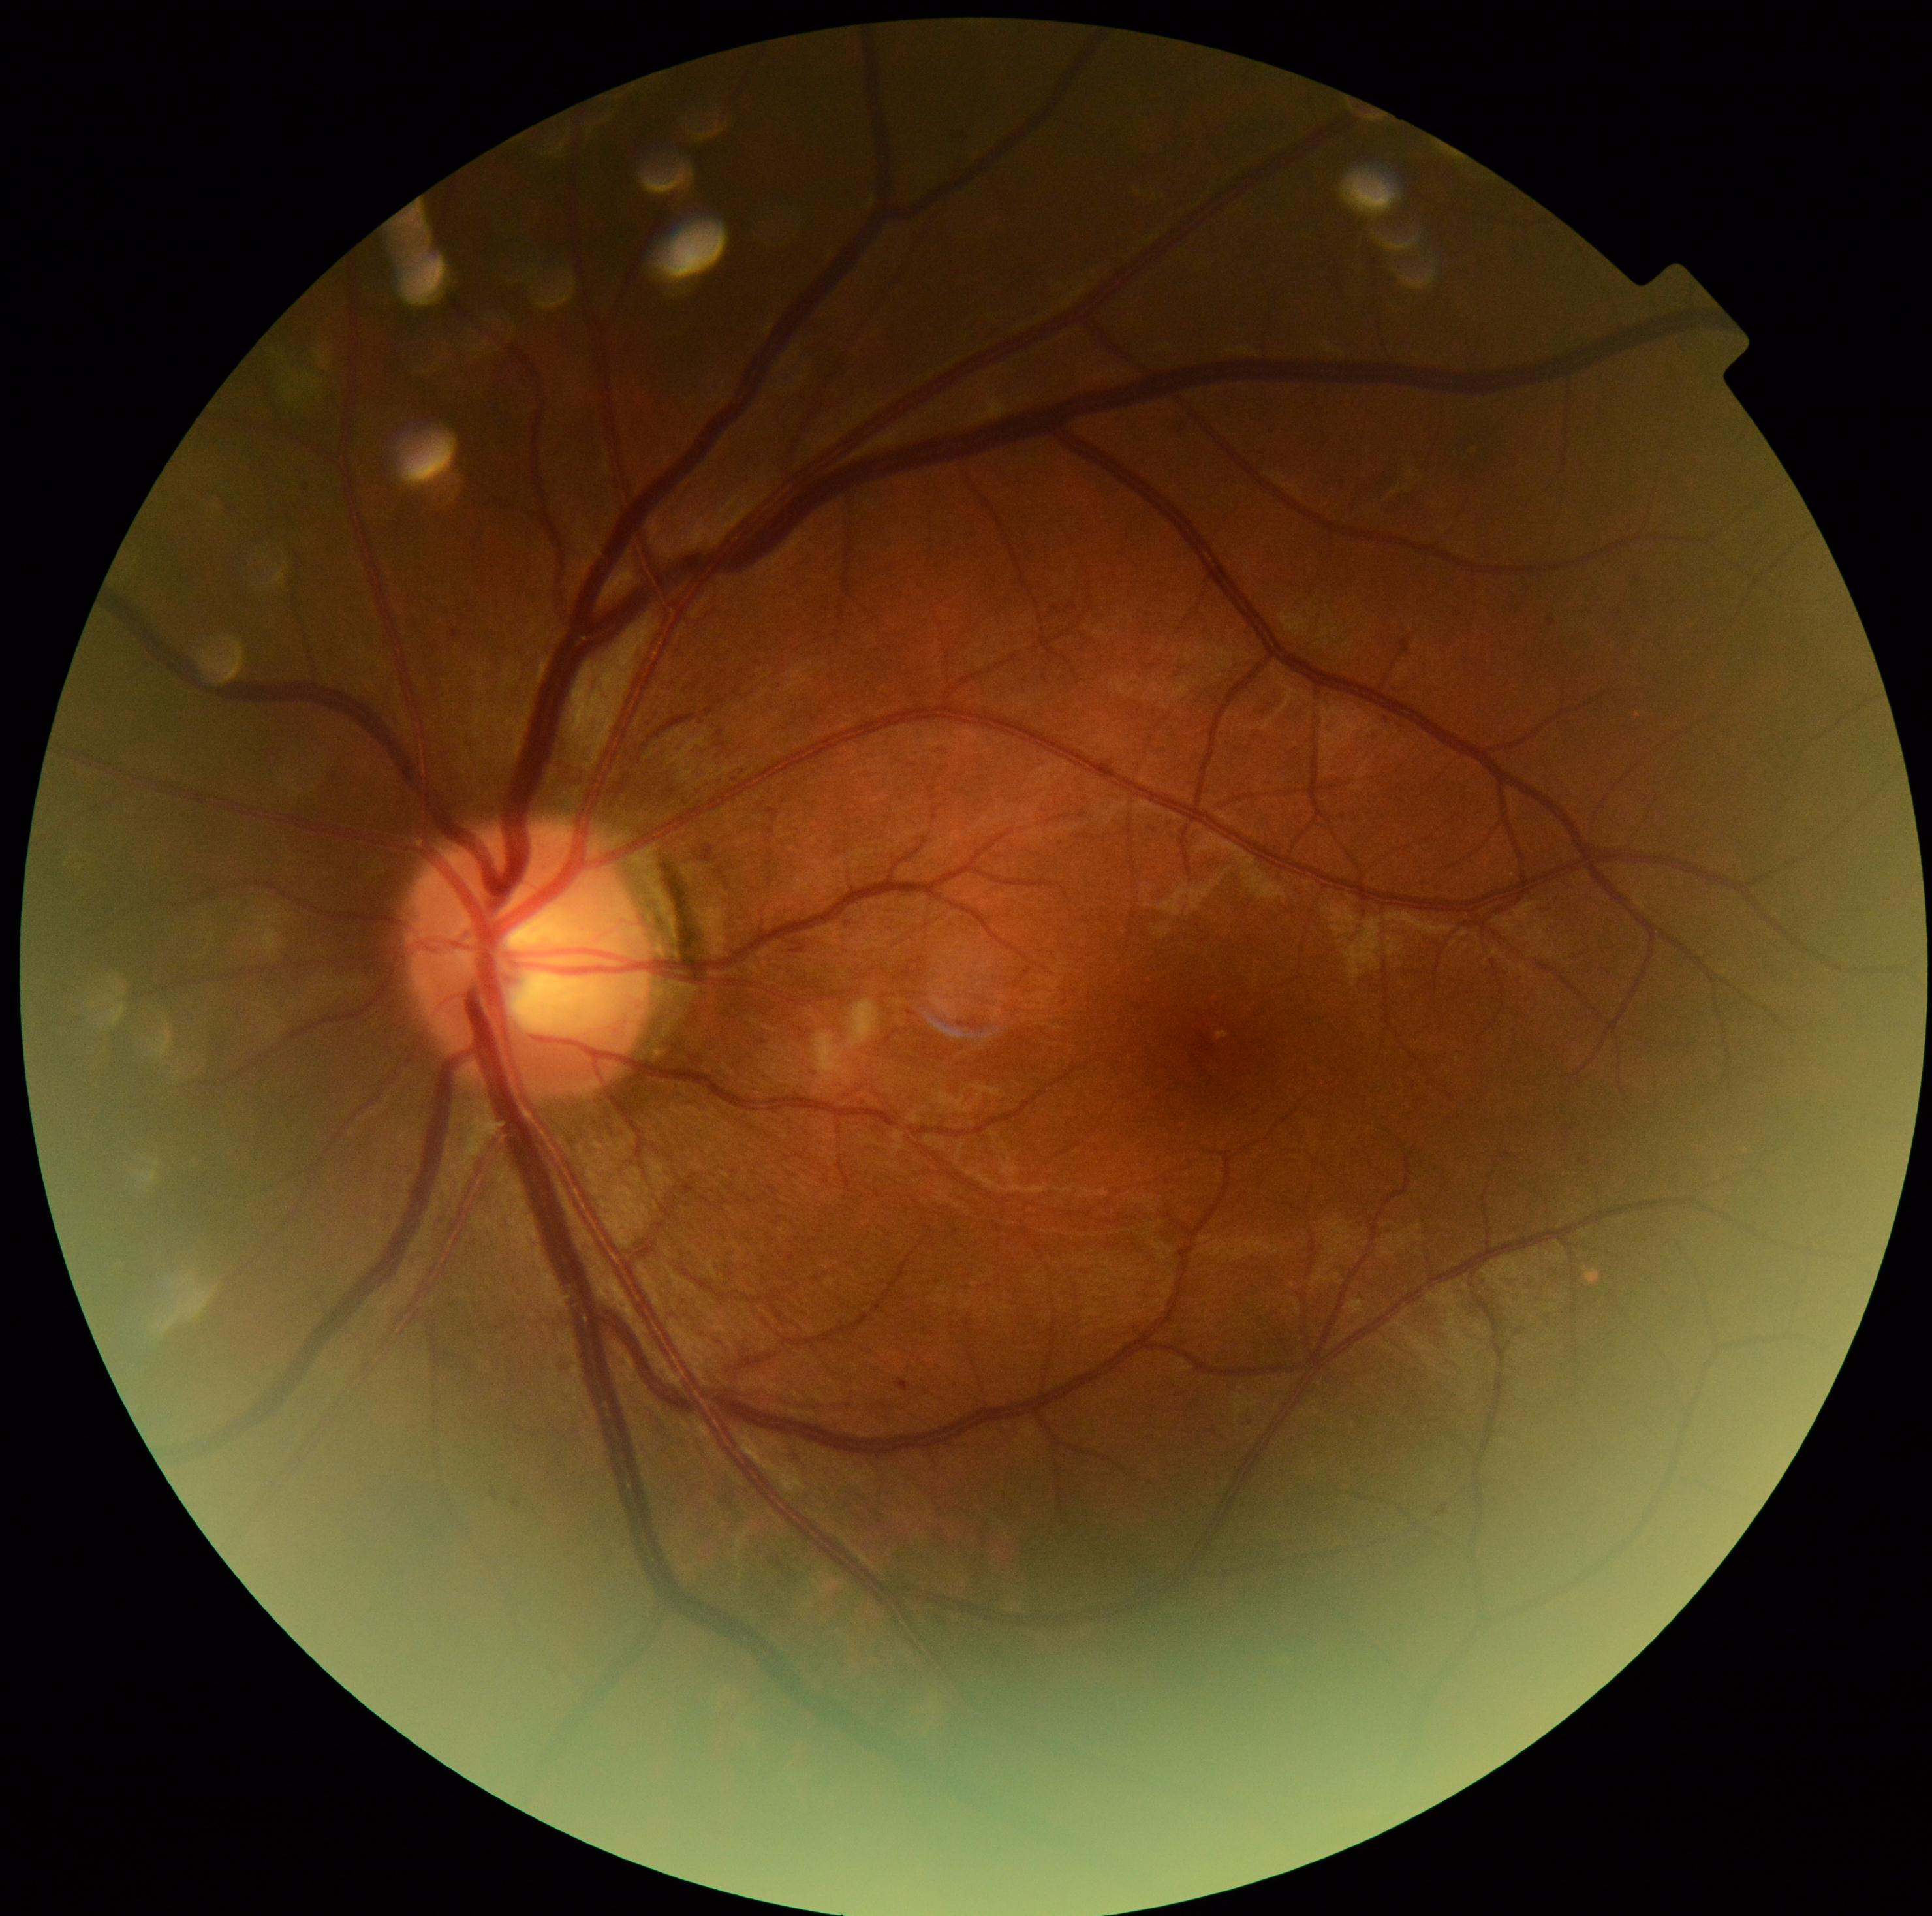 Annotations:
• DR severity — 2
• DR class — non-proliferative diabetic retinopathy